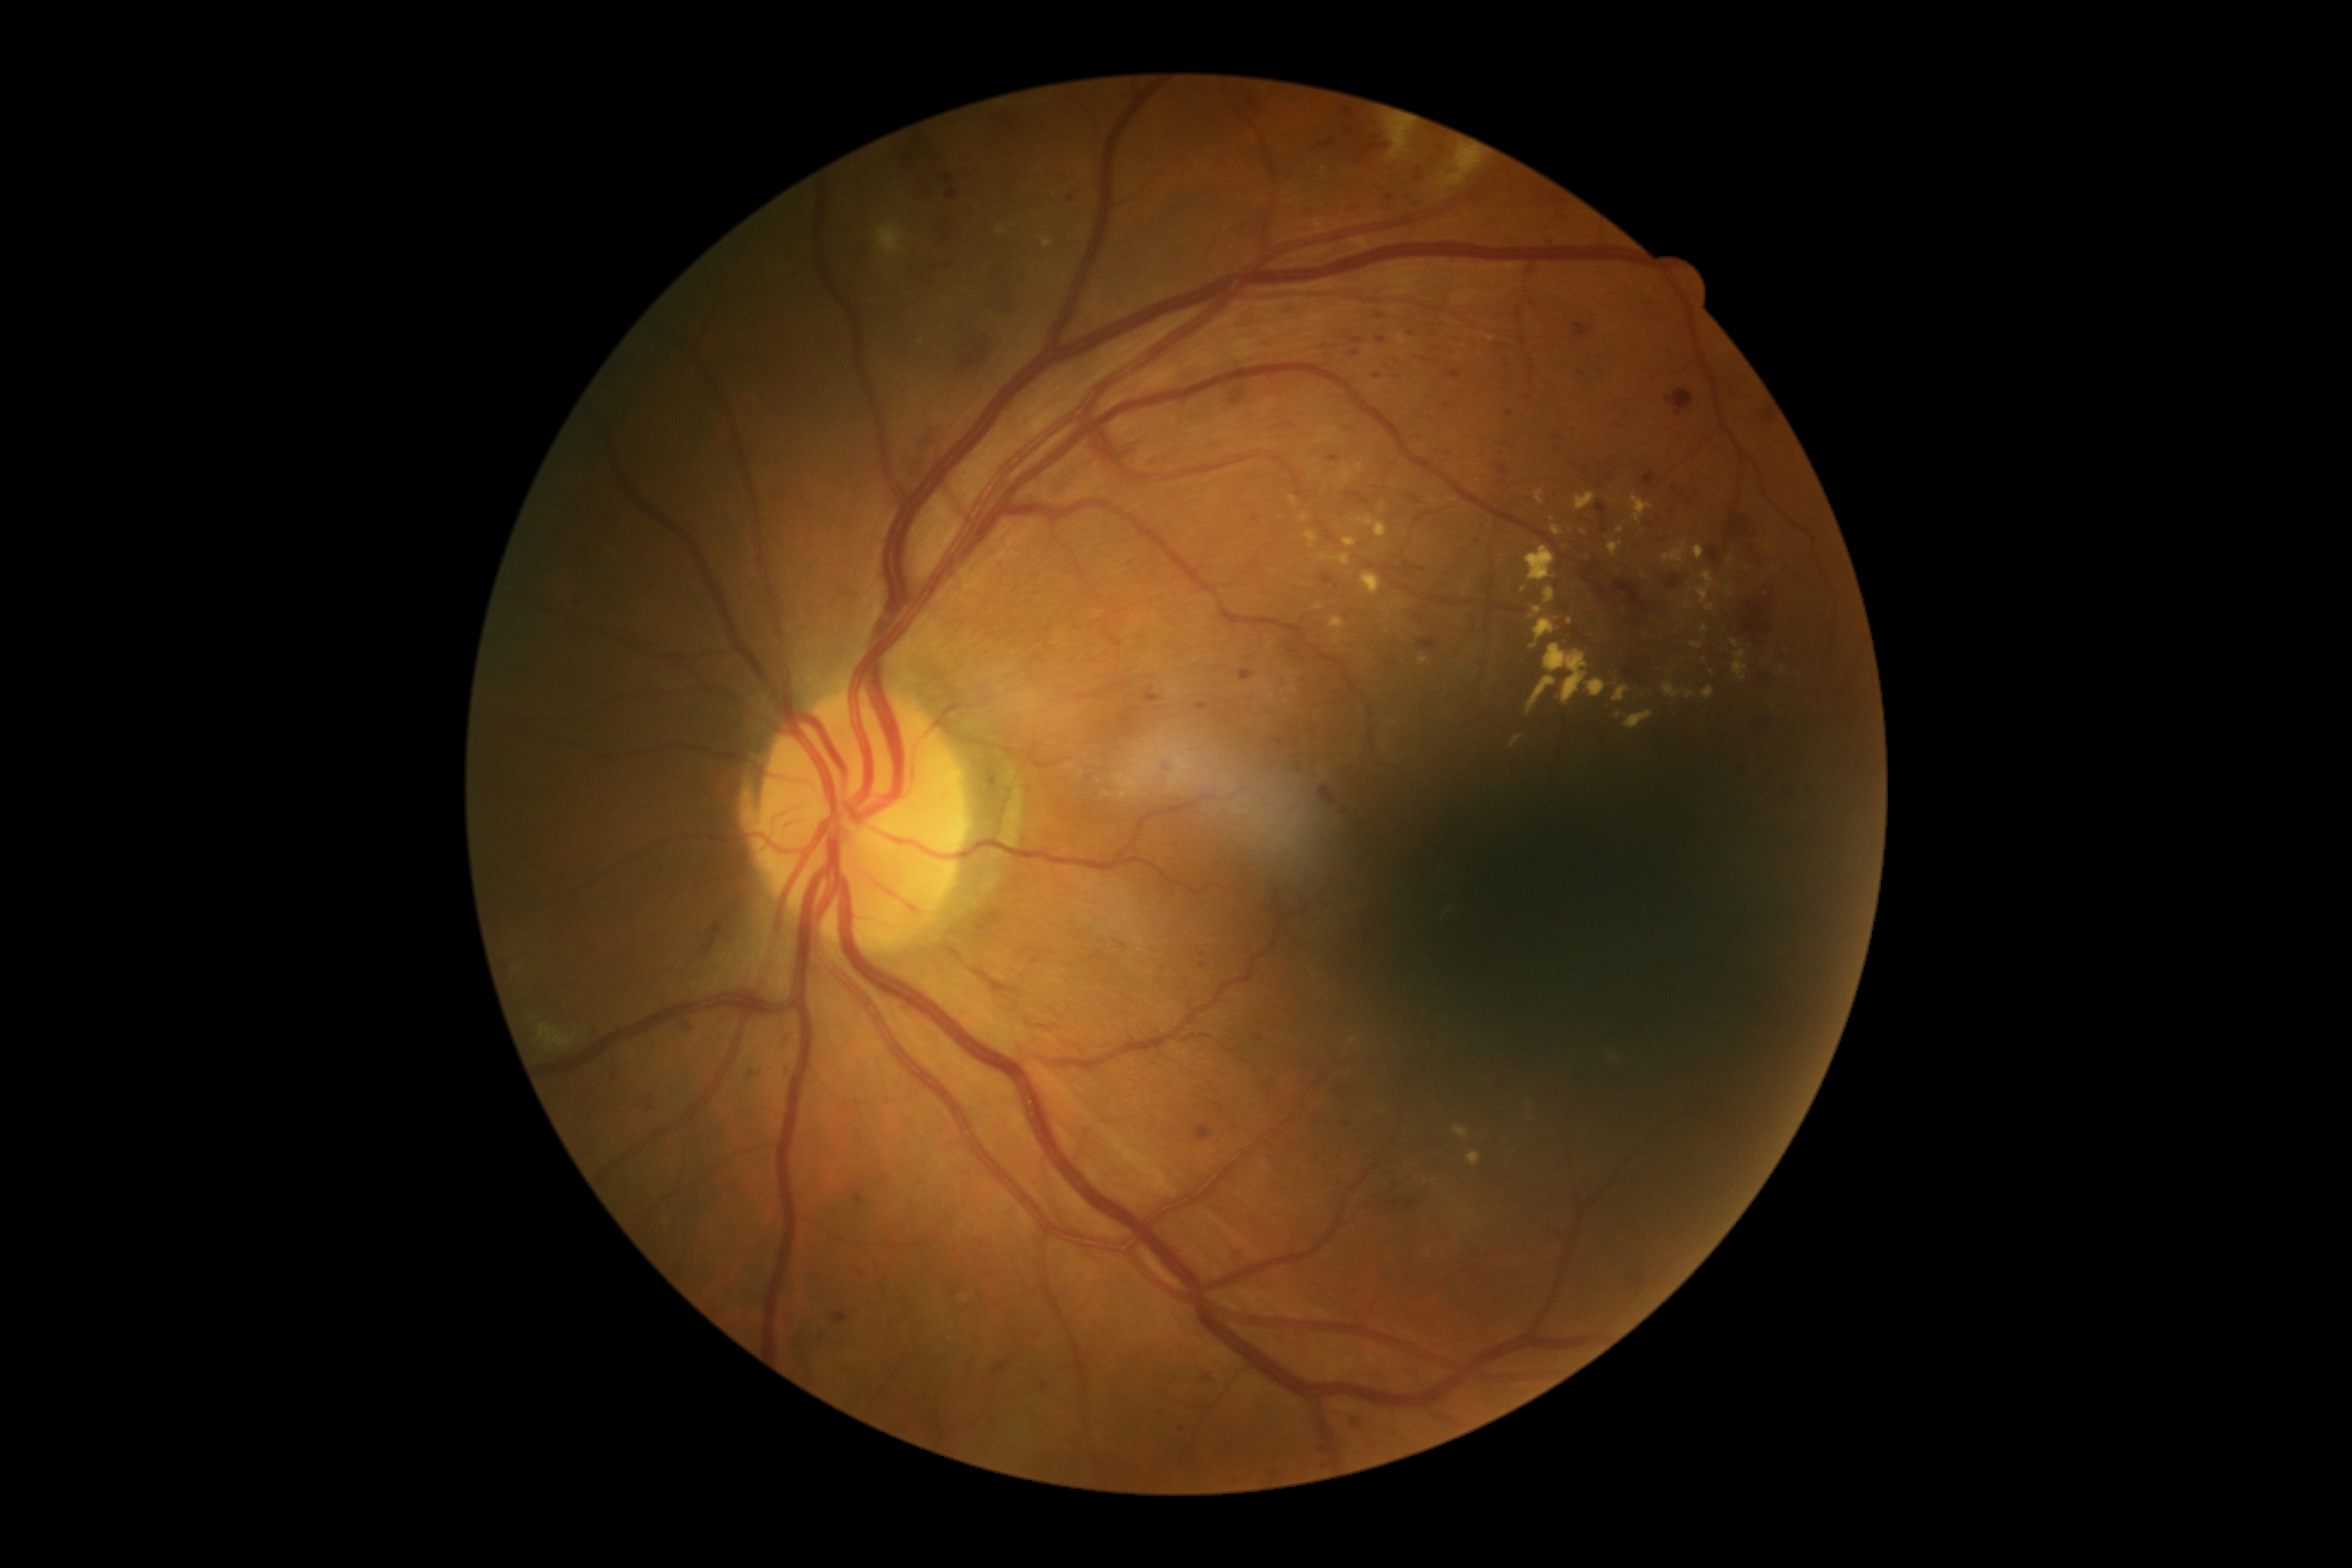
  dr_grade: grade 2 (moderate NPDR)